45° FOV. 2352 by 1568 pixels — 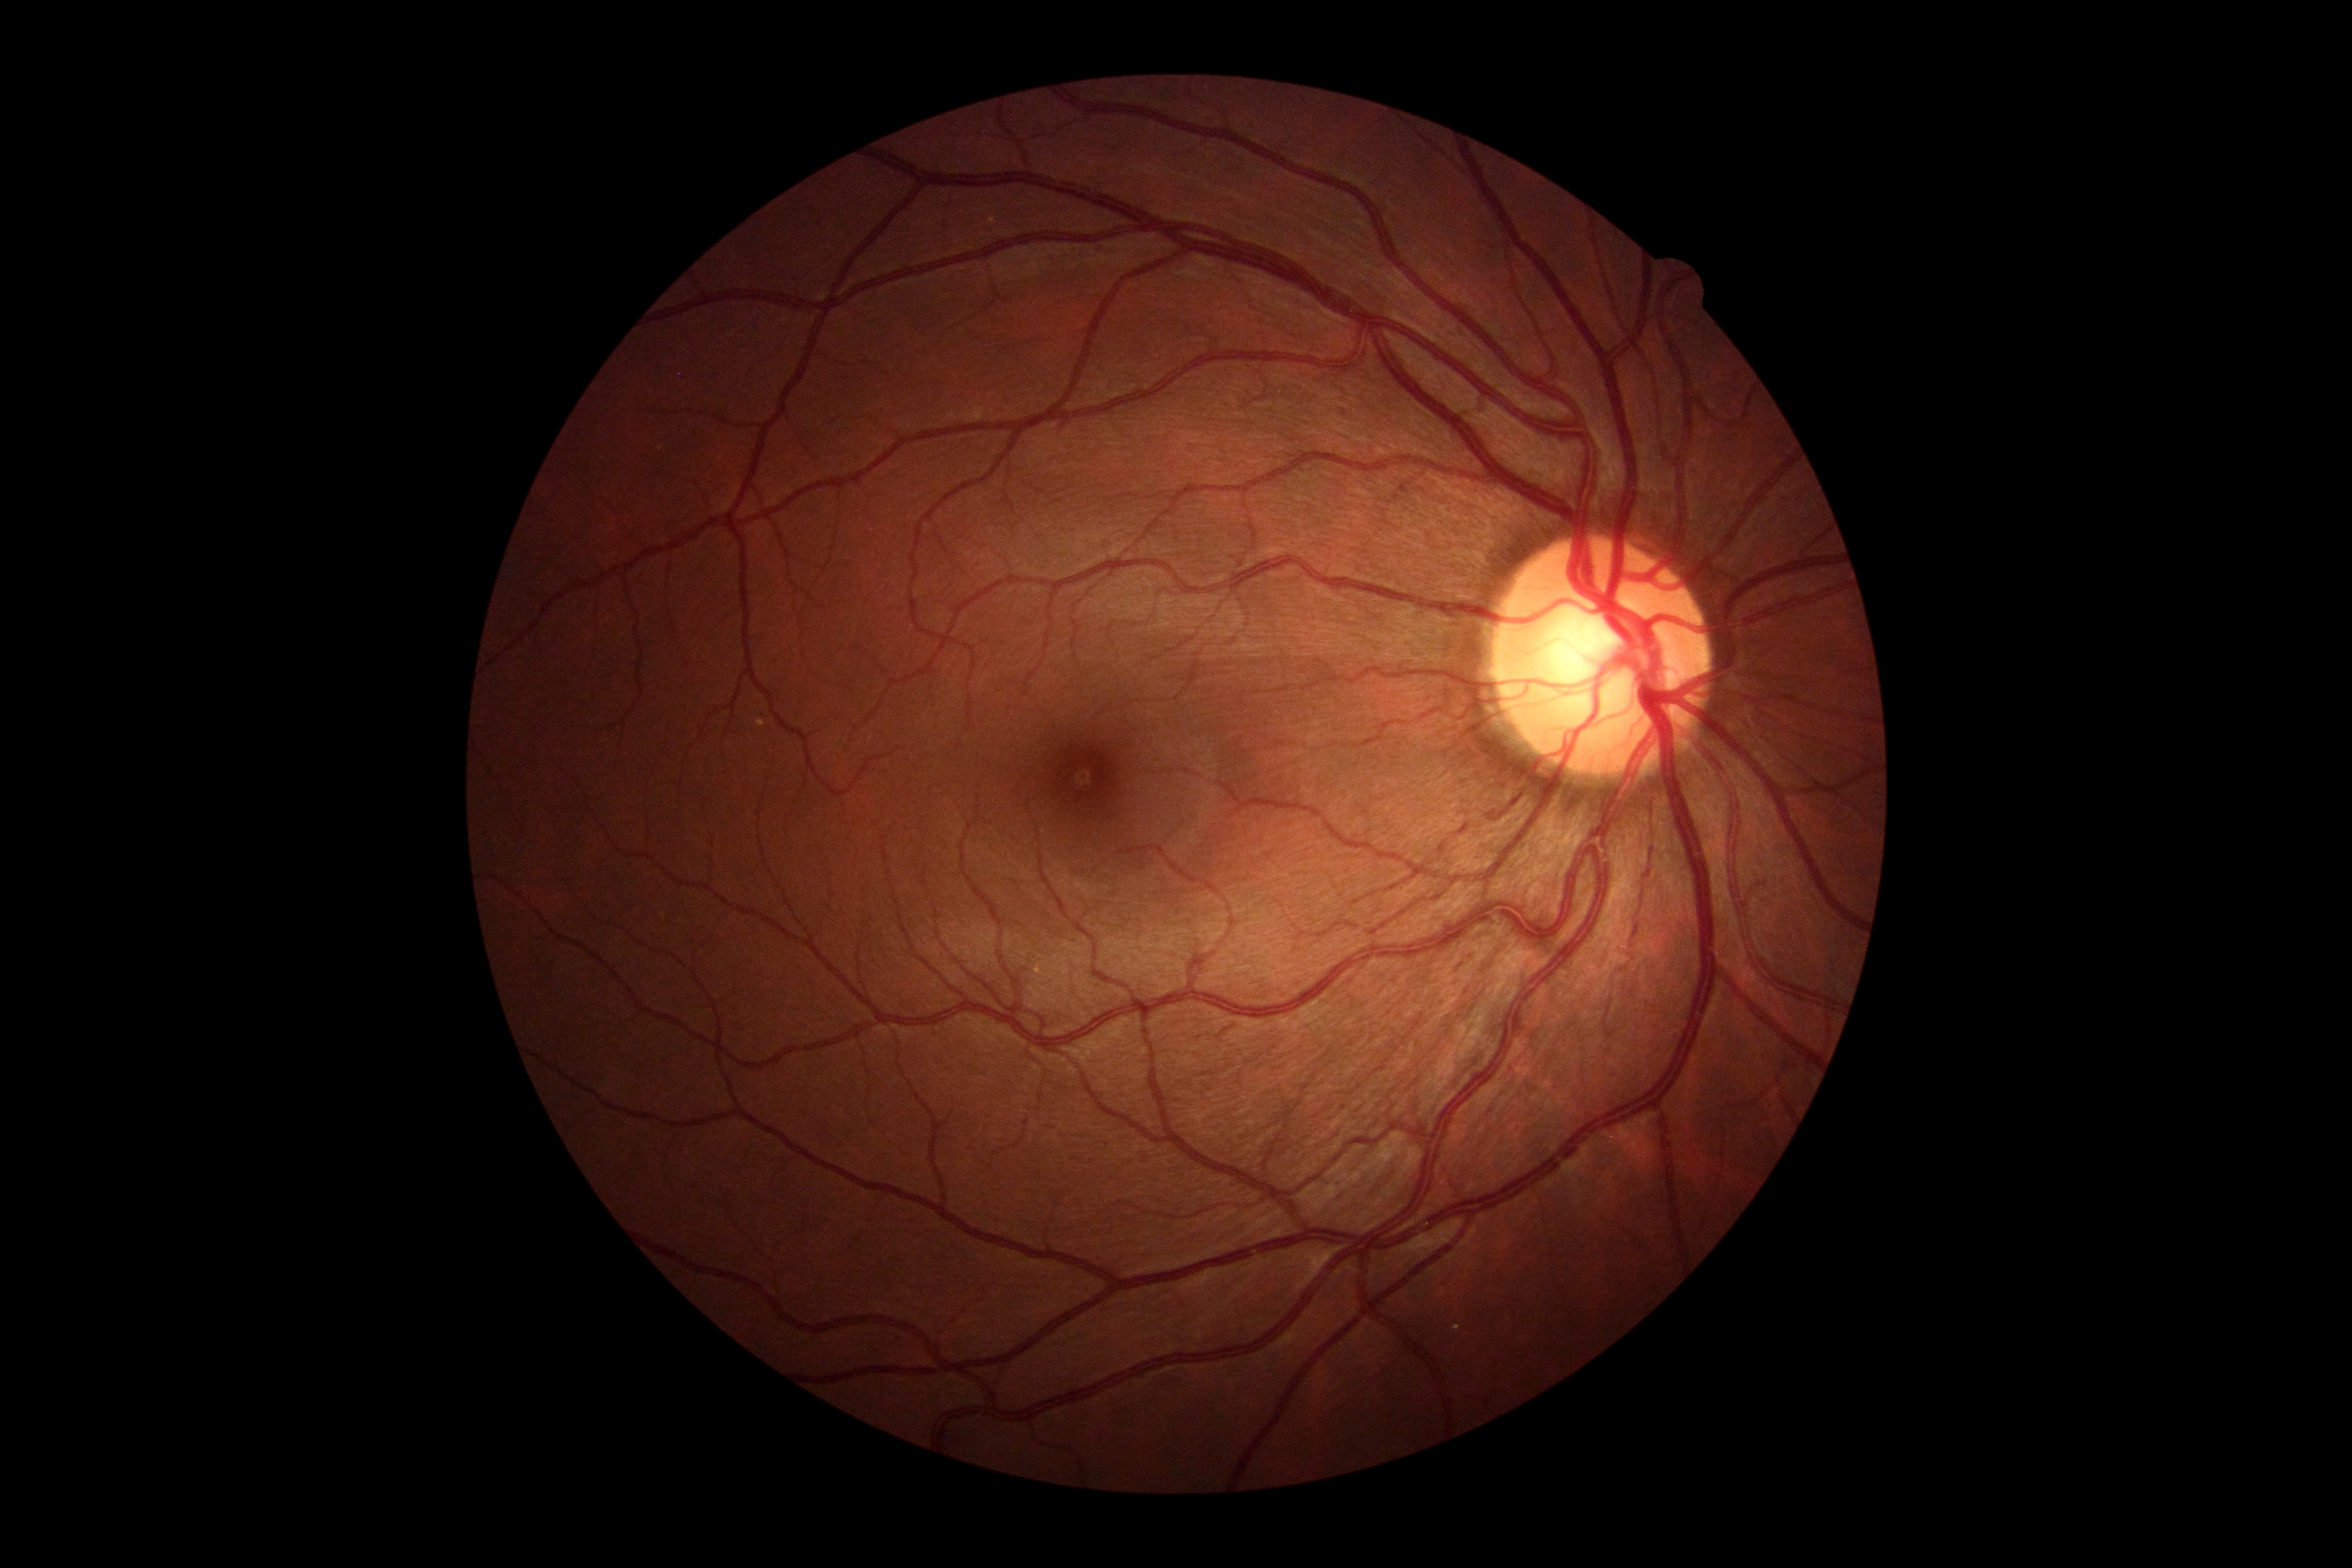 Diabetic retinopathy grade: 0 (no apparent retinopathy).